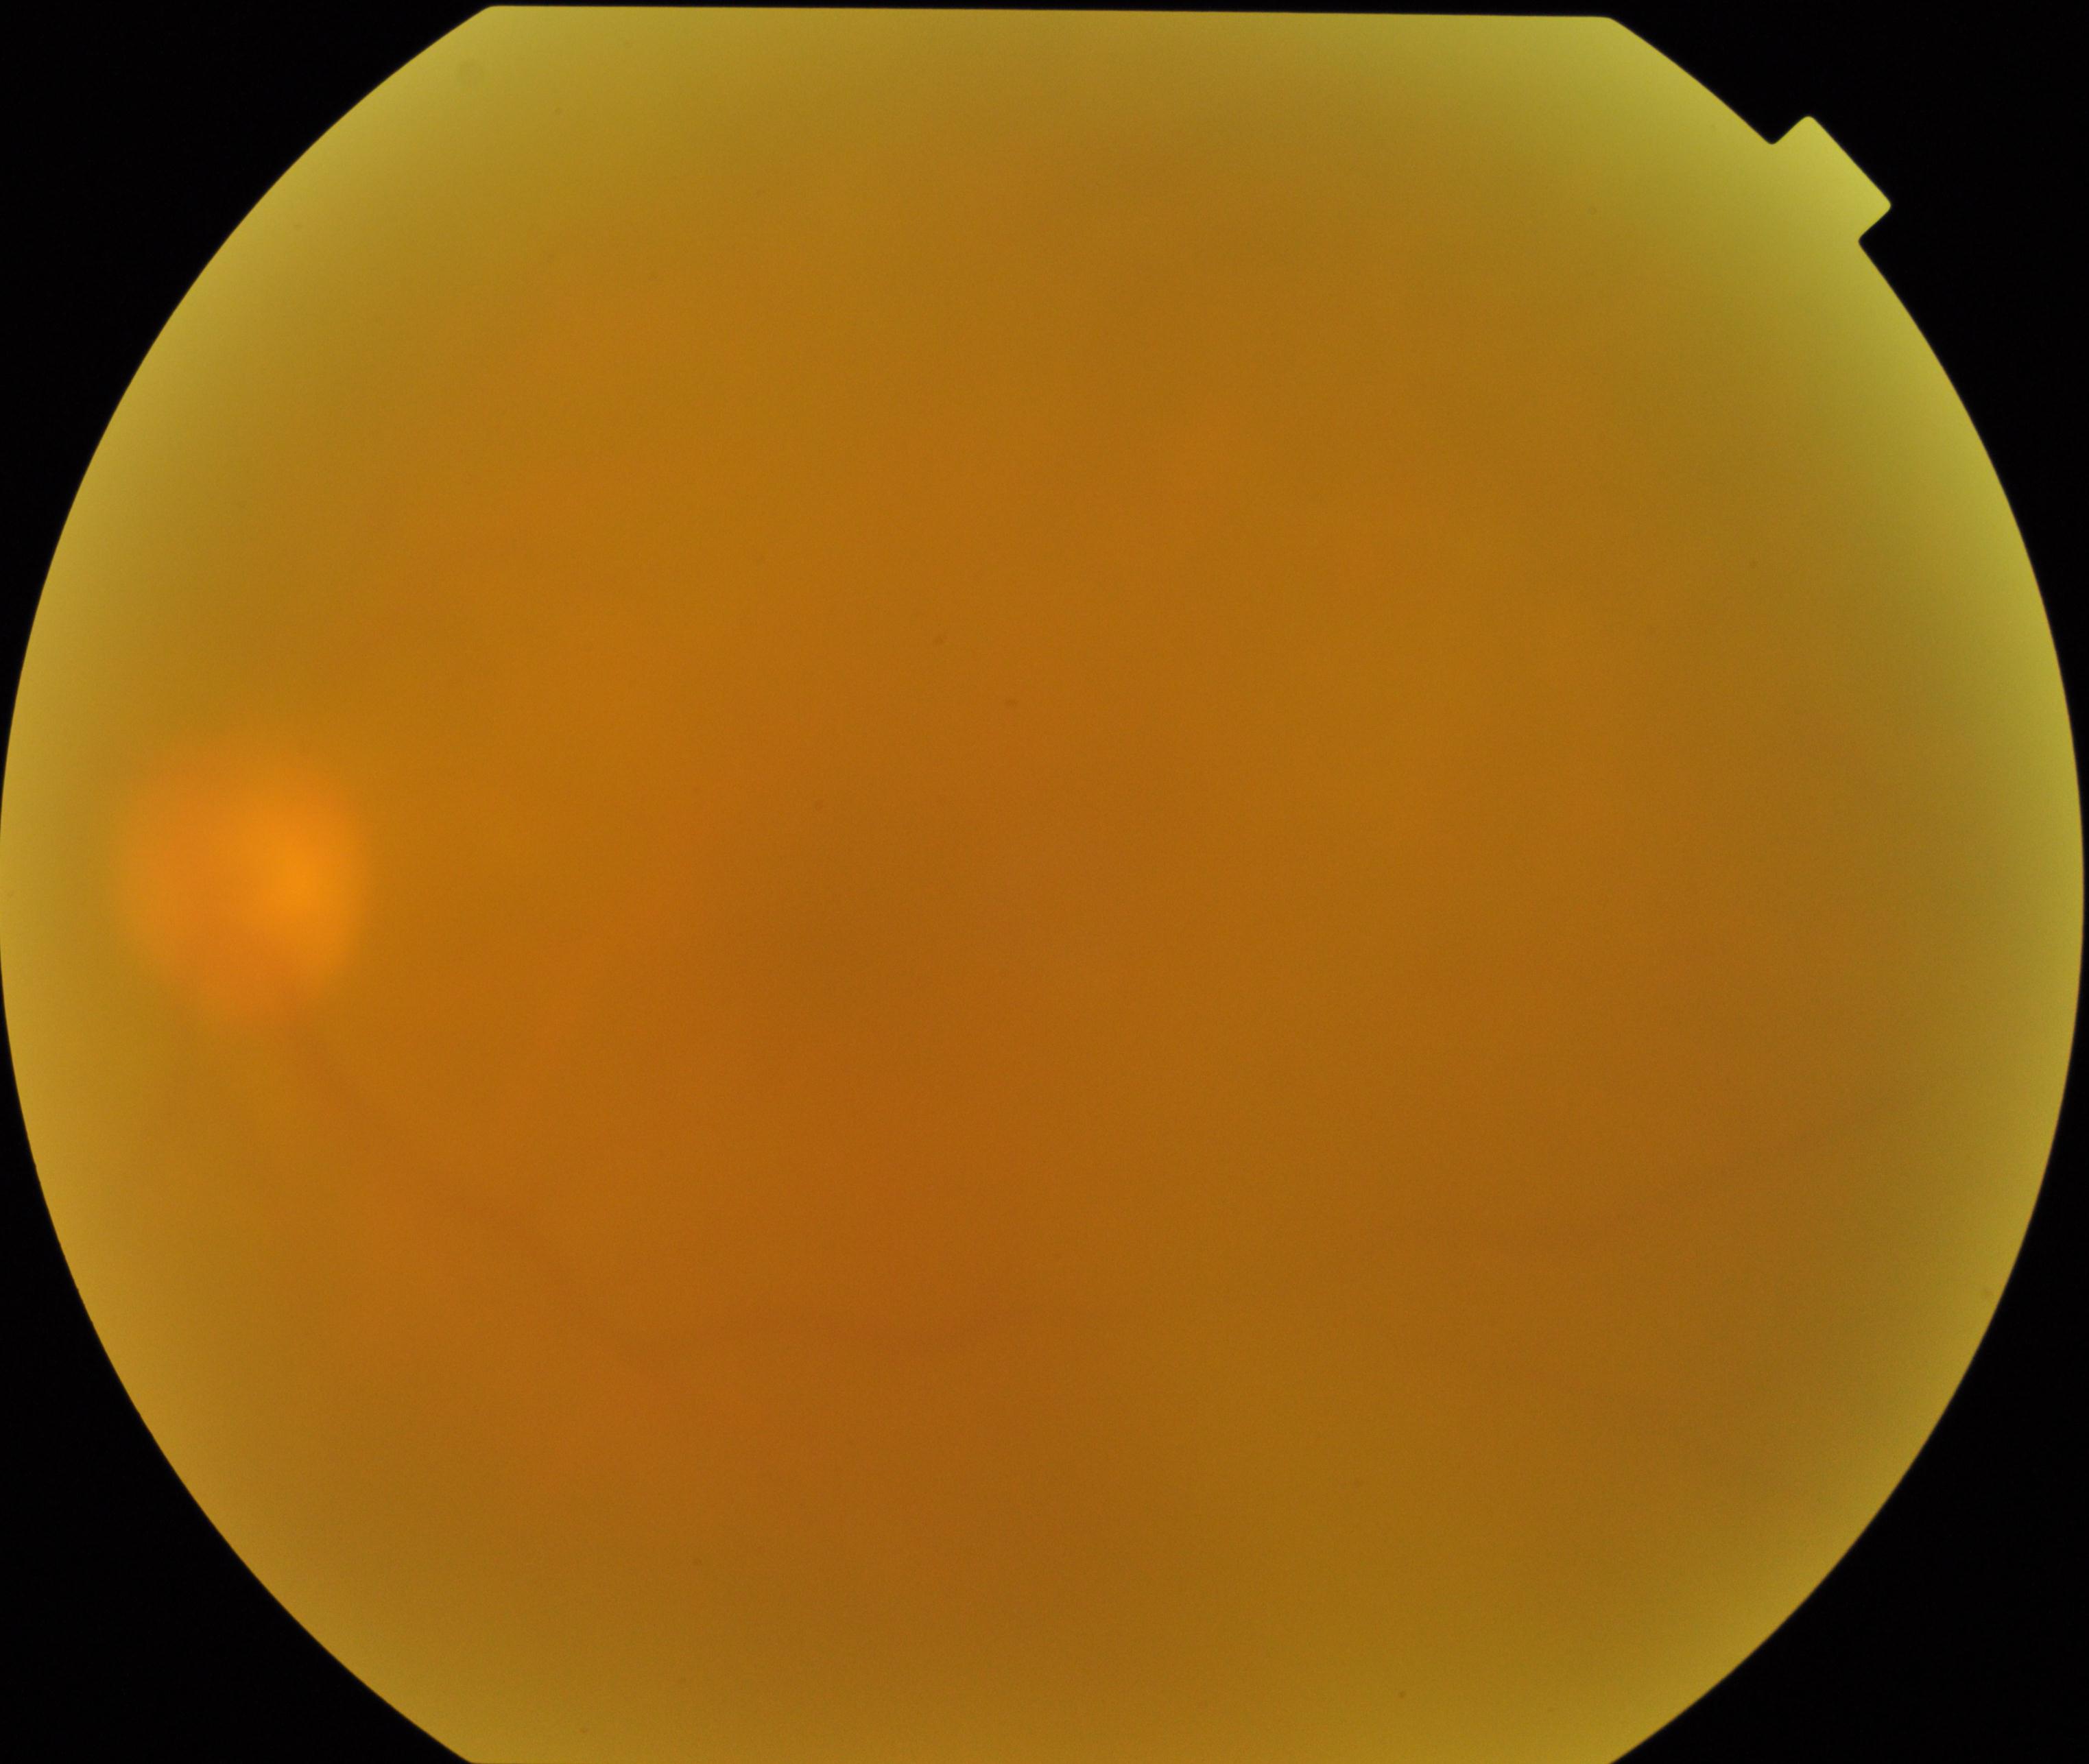
Blurred fundus image with substantial obscuration of retinal landmarks. No proliferative diabetic retinopathy identified.